Optic nerve head photograph:
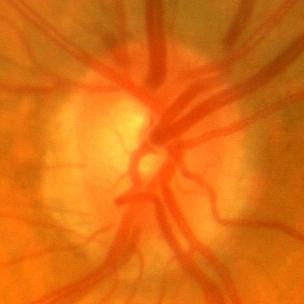 Findings consistent with no evidence of glaucoma.